45° field of view · image size 2048x1536 — 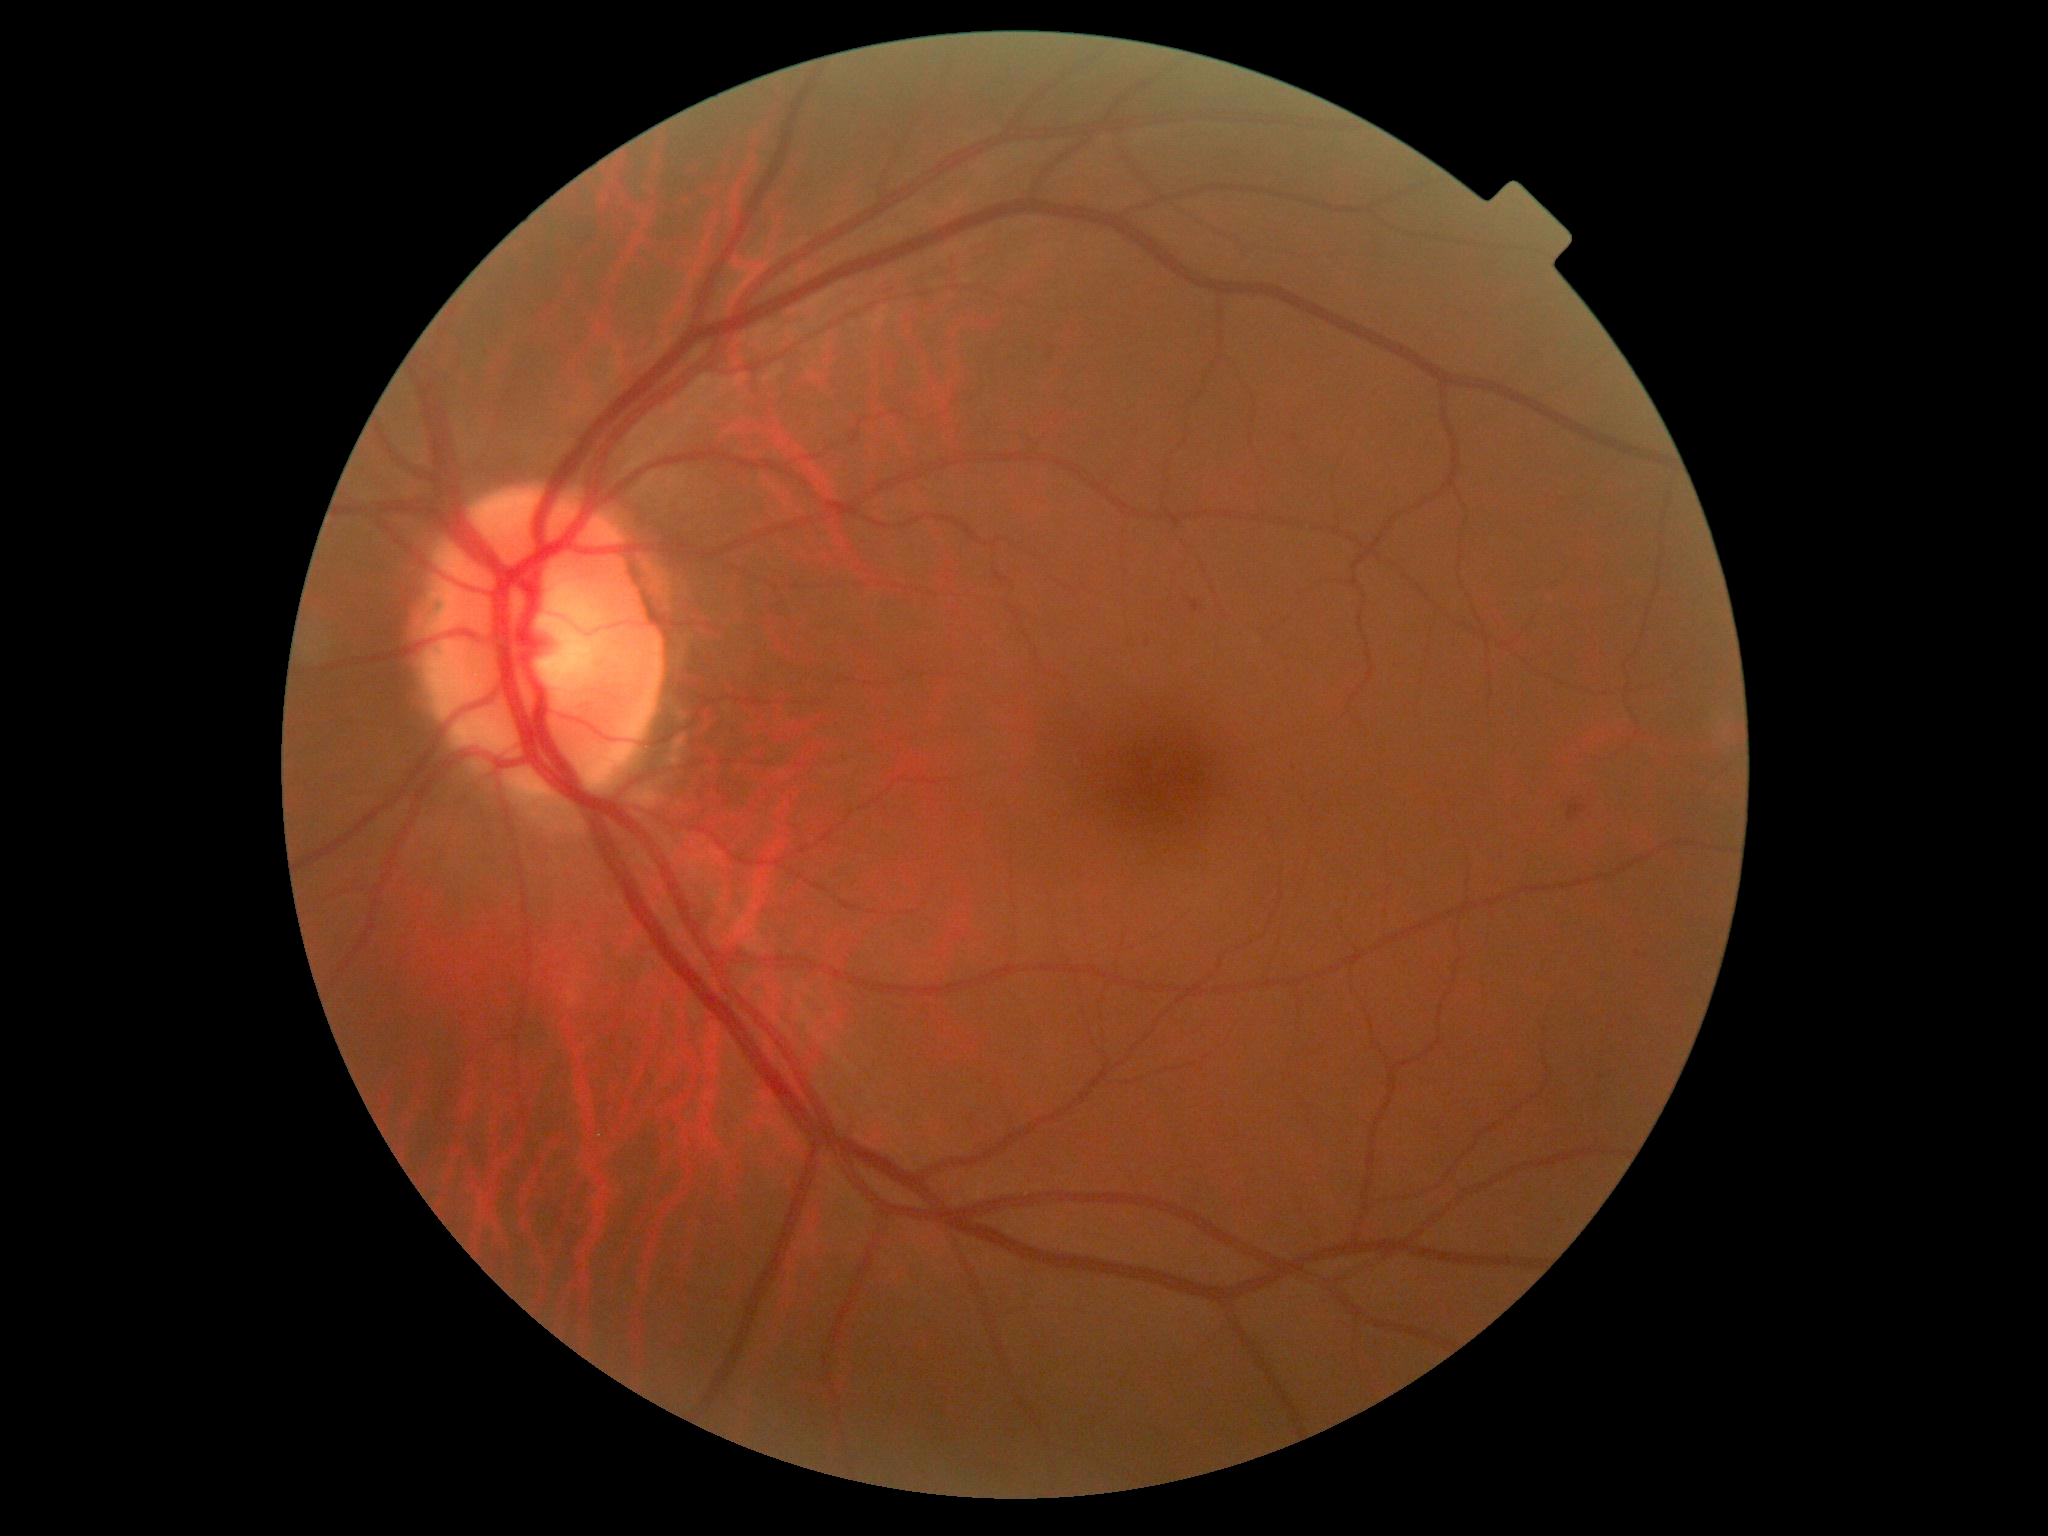
diabetic retinopathy severity: grade 2 (moderate NPDR), DR class: non-proliferative diabetic retinopathy.